Color fundus image; 45° field of view.
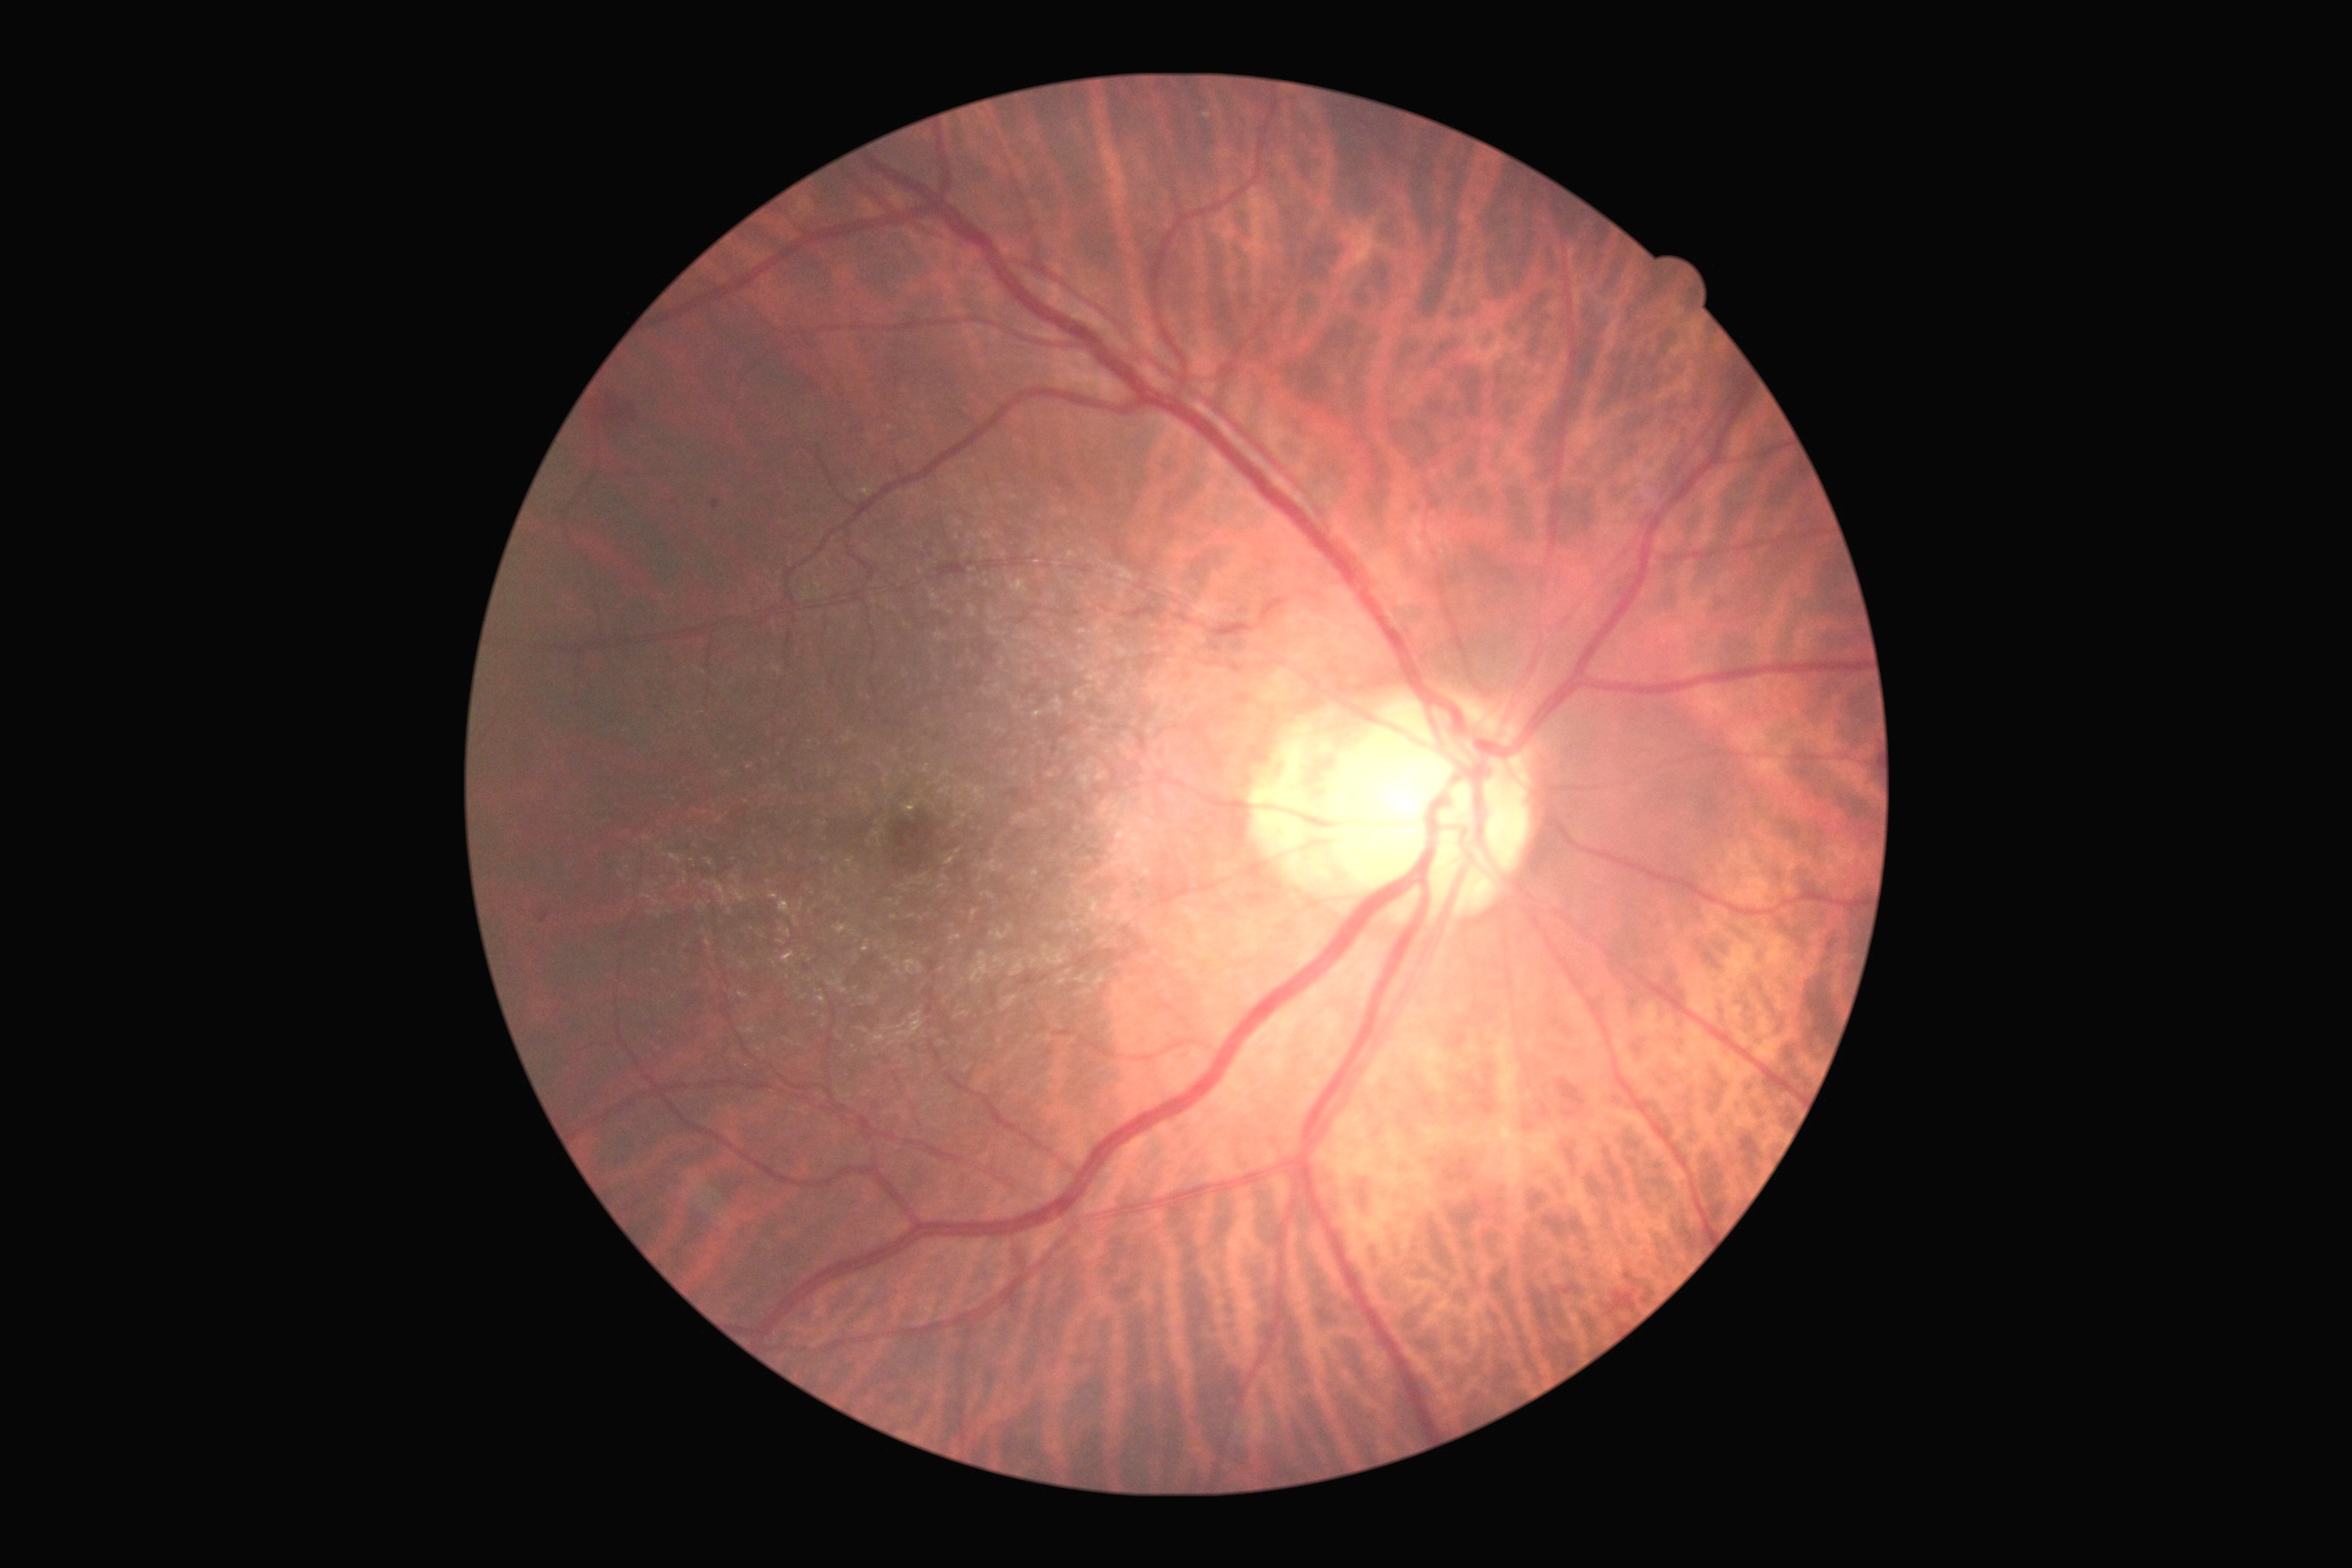

DR grade is moderate non-proliferative diabetic retinopathy (2). Disease class: non-proliferative diabetic retinopathy.